Tabletop color fundus camera image · 45-degree field of view:
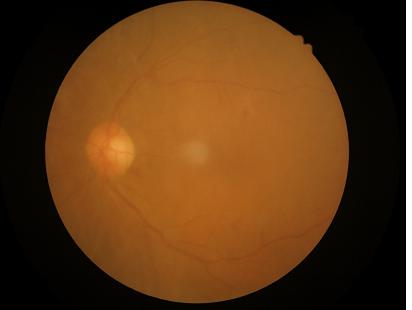 Quality grading:
- illumination/color: no over- or under-exposure
- overall: poor and difficult to use diagnostically
- contrast: narrow intensity range, structures hard to distinguish
- sharpness: noticeable blur in the optic disc, vessels, or background